Nonmydriatic. Color fundus image. 848x848 — 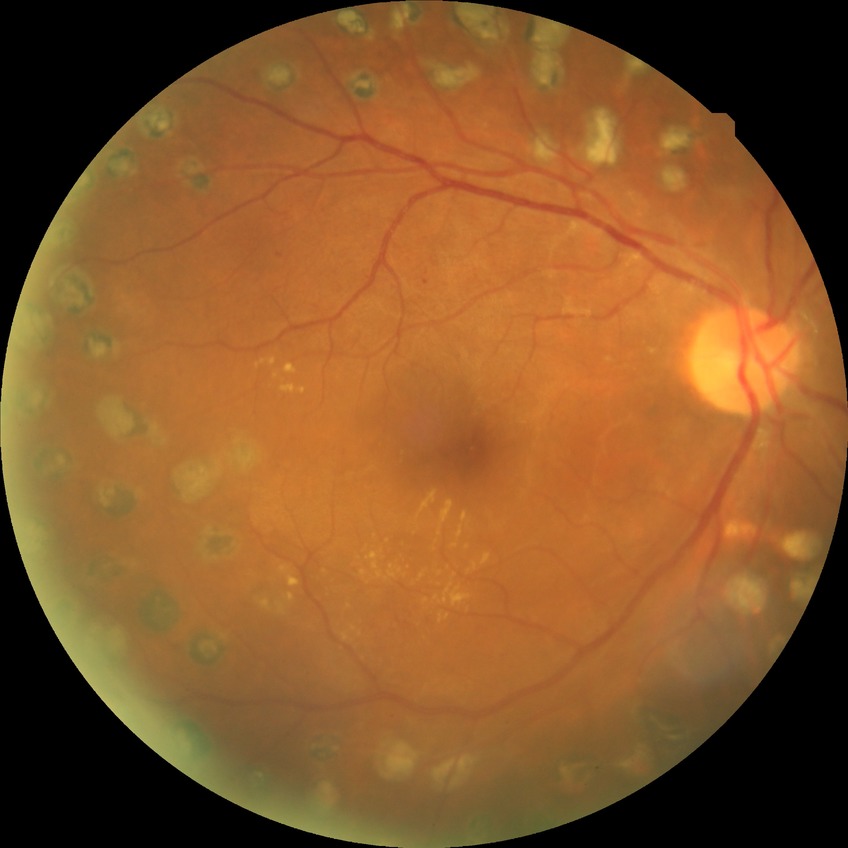
Diabetic retinopathy (DR) is proliferative diabetic retinopathy (PDR).